Image size 1240x1240. Pediatric retinal photograph (wide-field). Acquired on the Phoenix ICON: 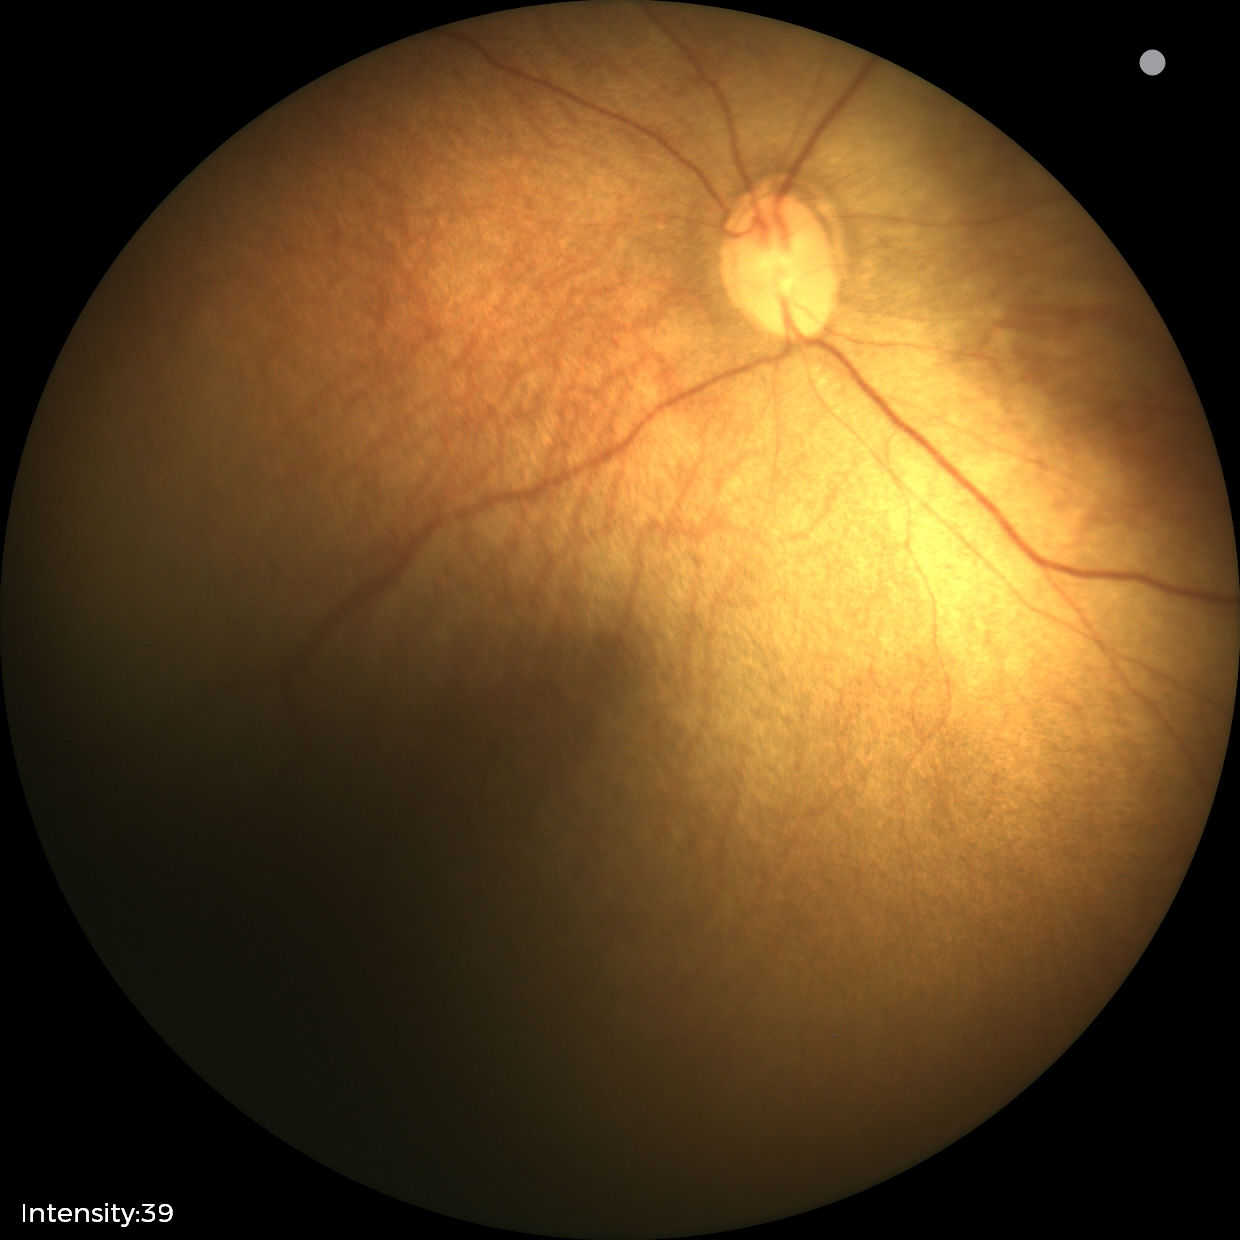
Normal screening examination.